Color fundus photograph: 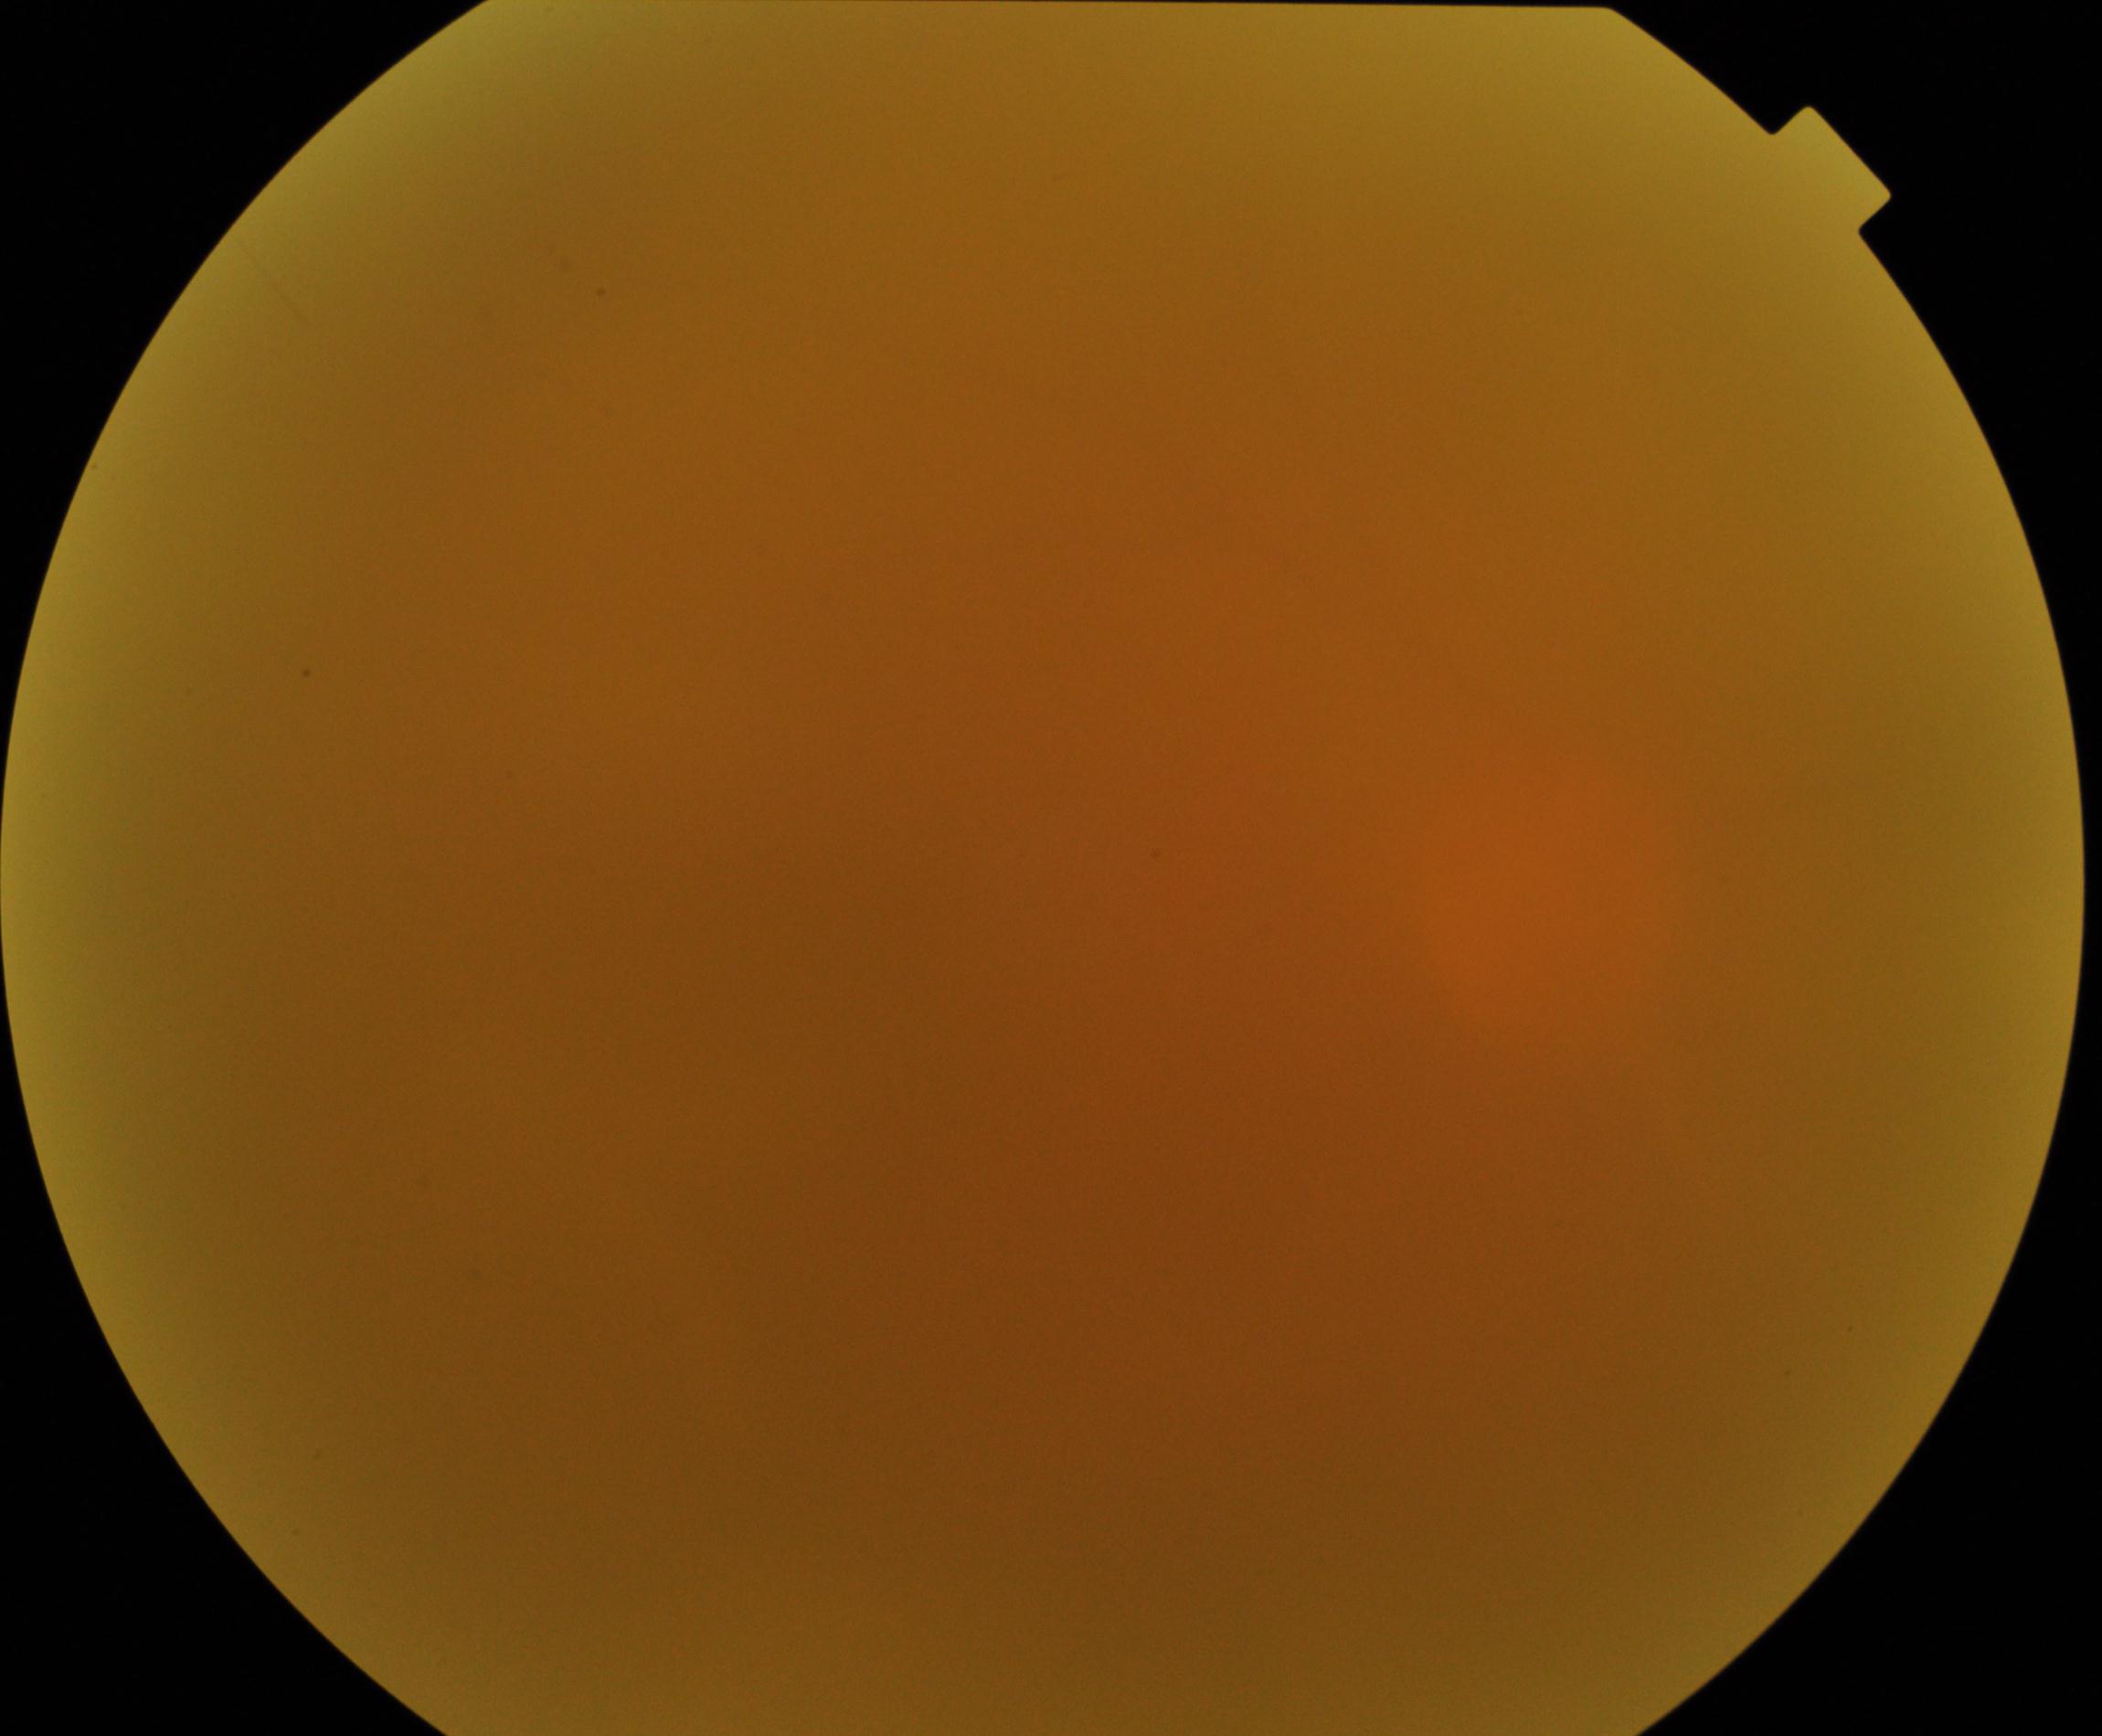
Image quality is poor; more than half the field is obscured. No evidence of proliferative diabetic retinopathy.